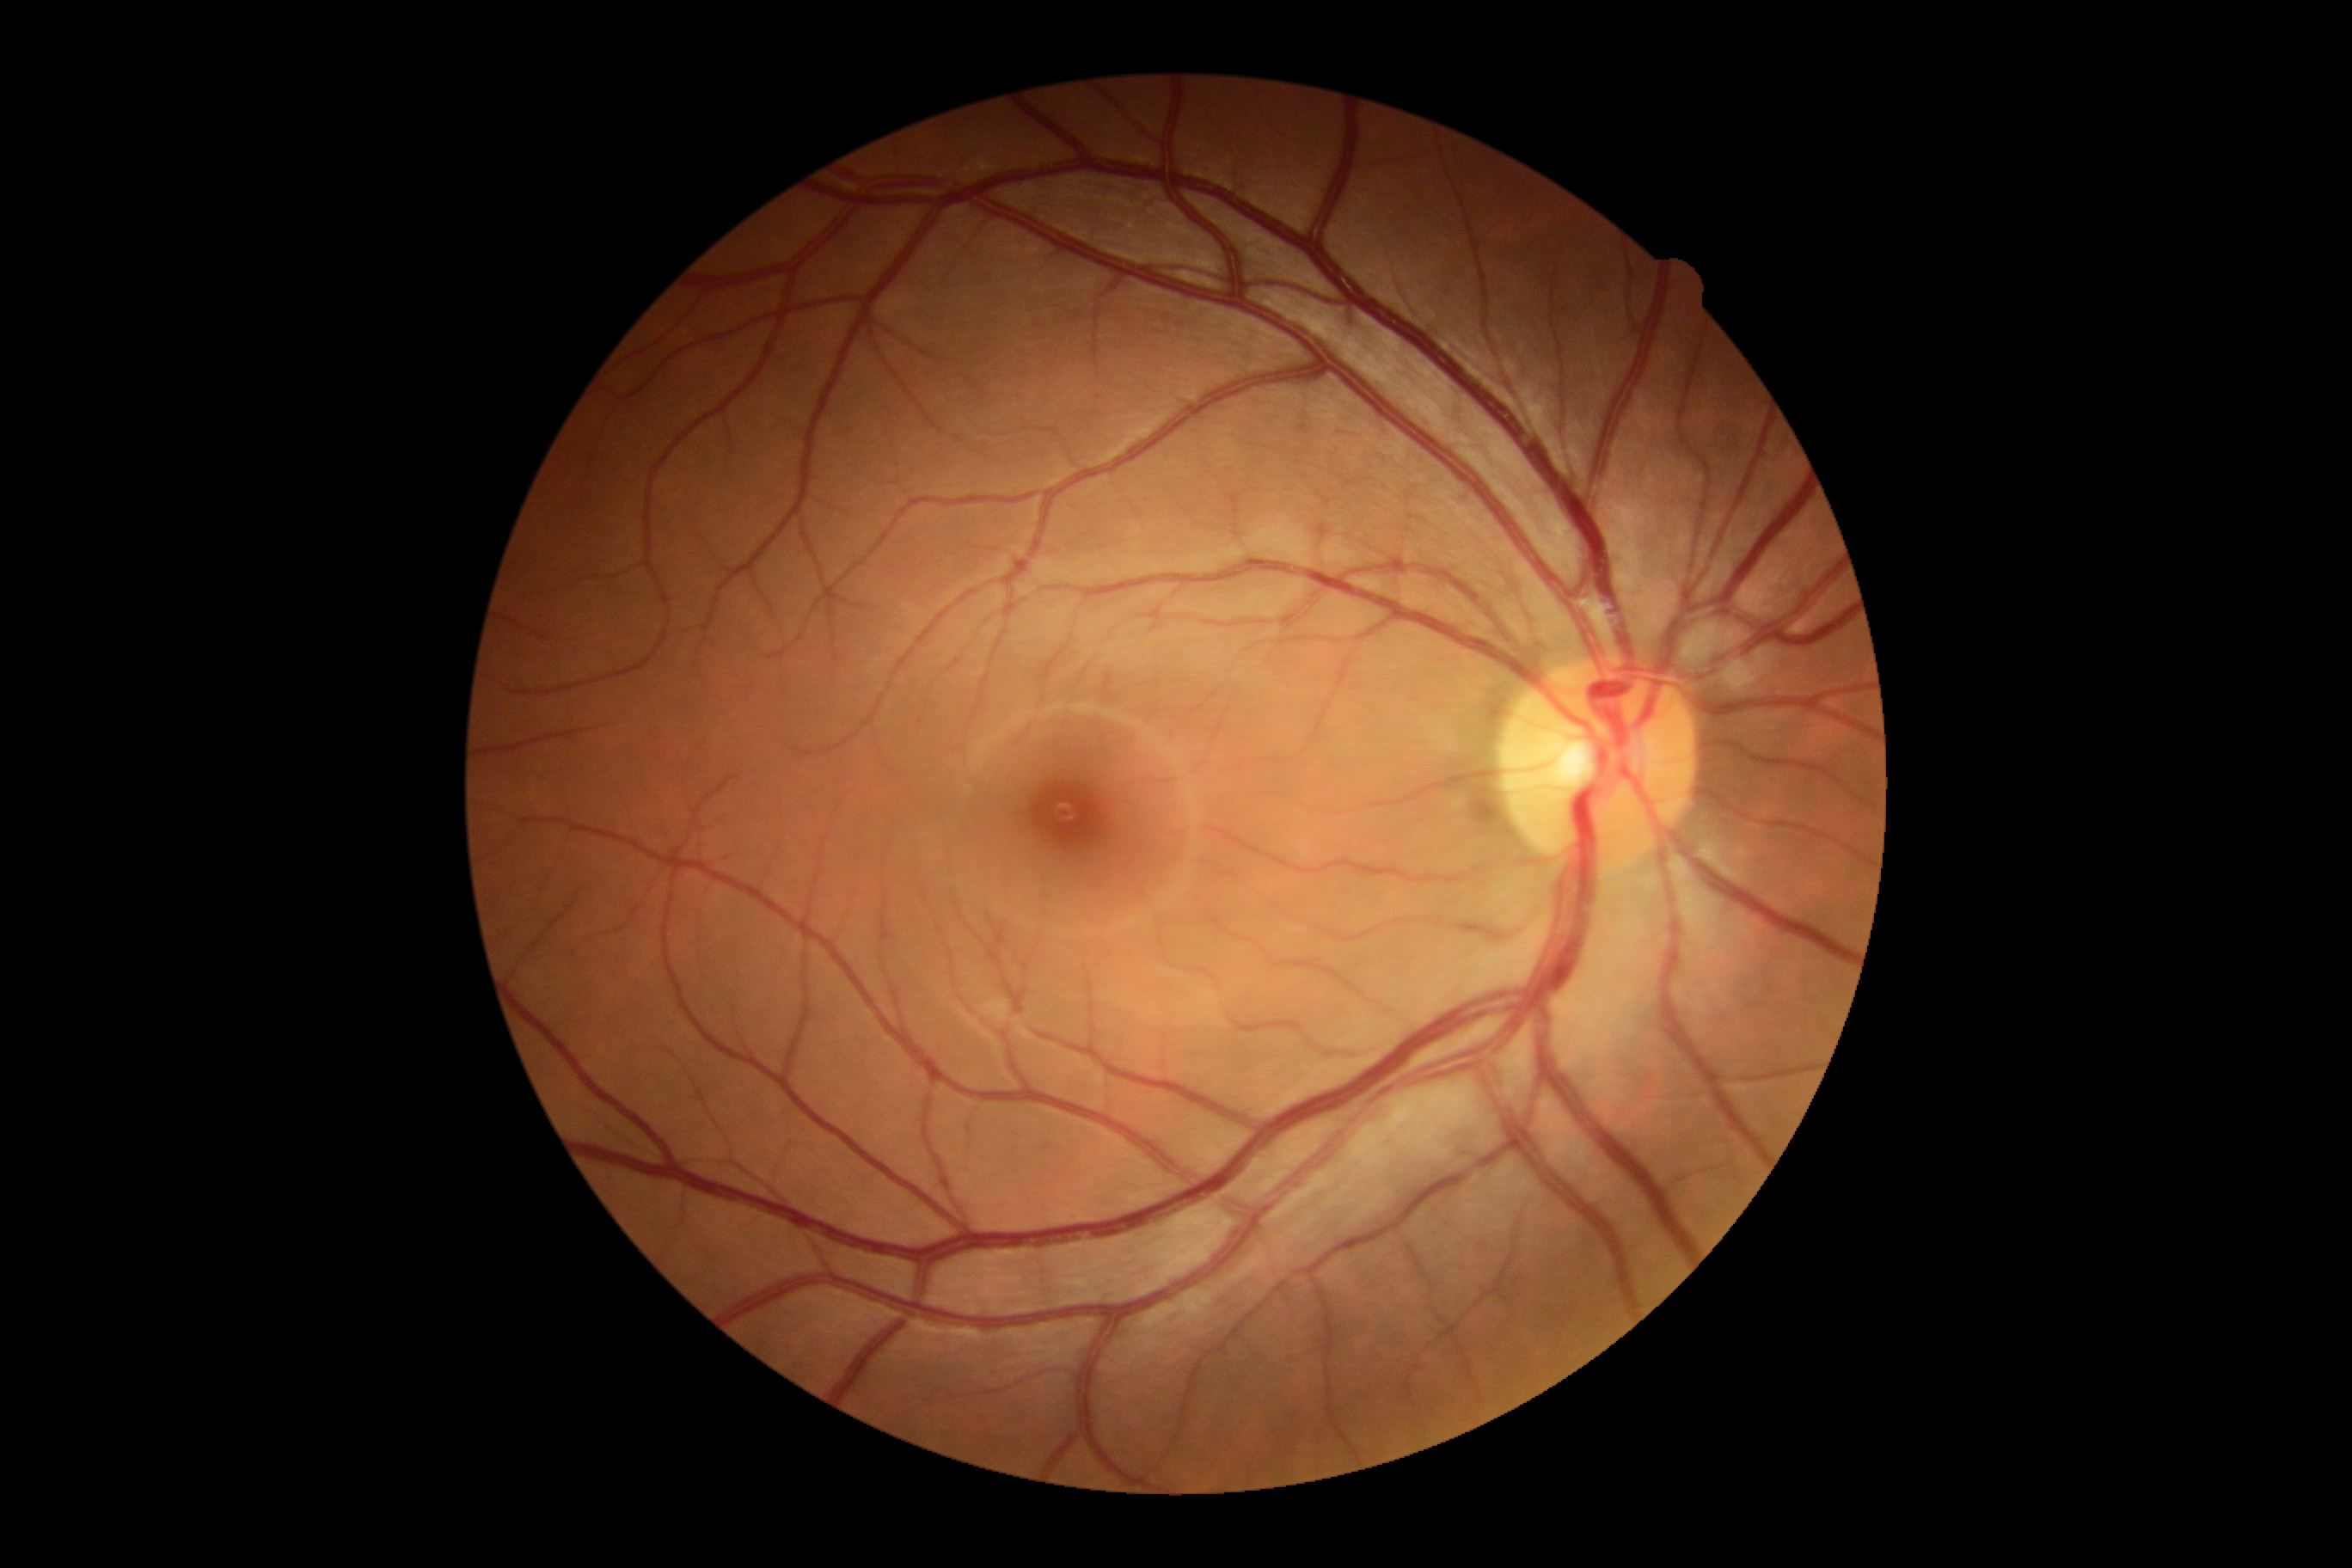 DR: grade 0.